Fundus photo:
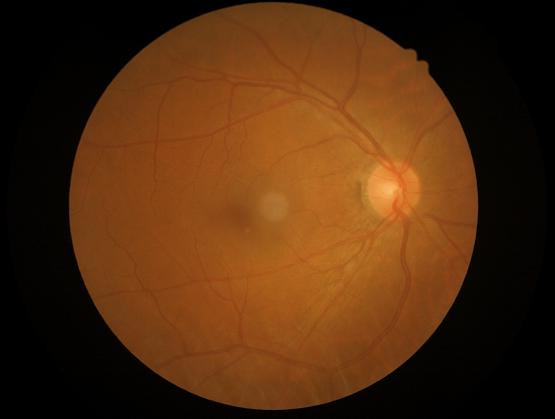
Even illumination with no color cast.
Contrast is good.
Acceptable image quality.